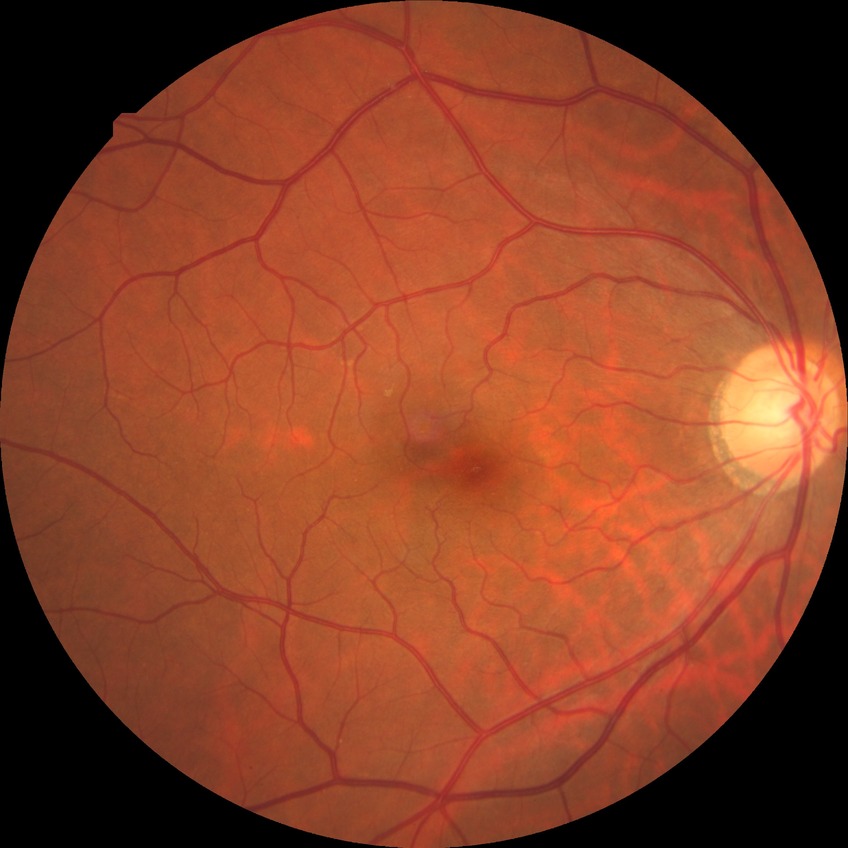
Diabetic retinopathy (DR) is NDR (no diabetic retinopathy).